Graded on the modified Davis scale
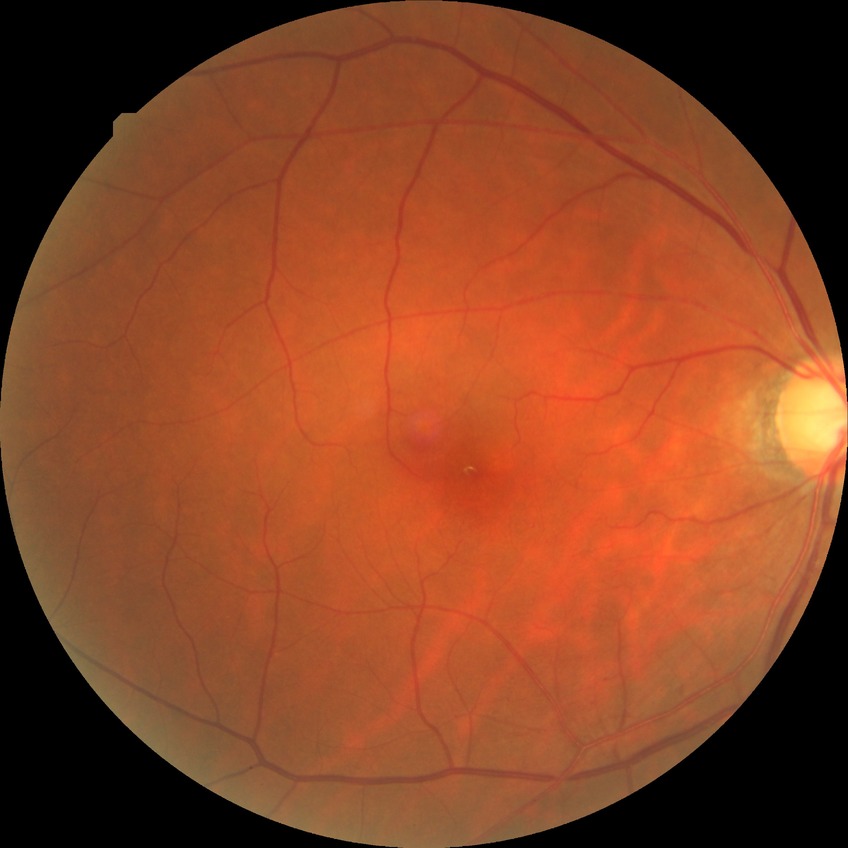

• retinopathy stage — no diabetic retinopathy